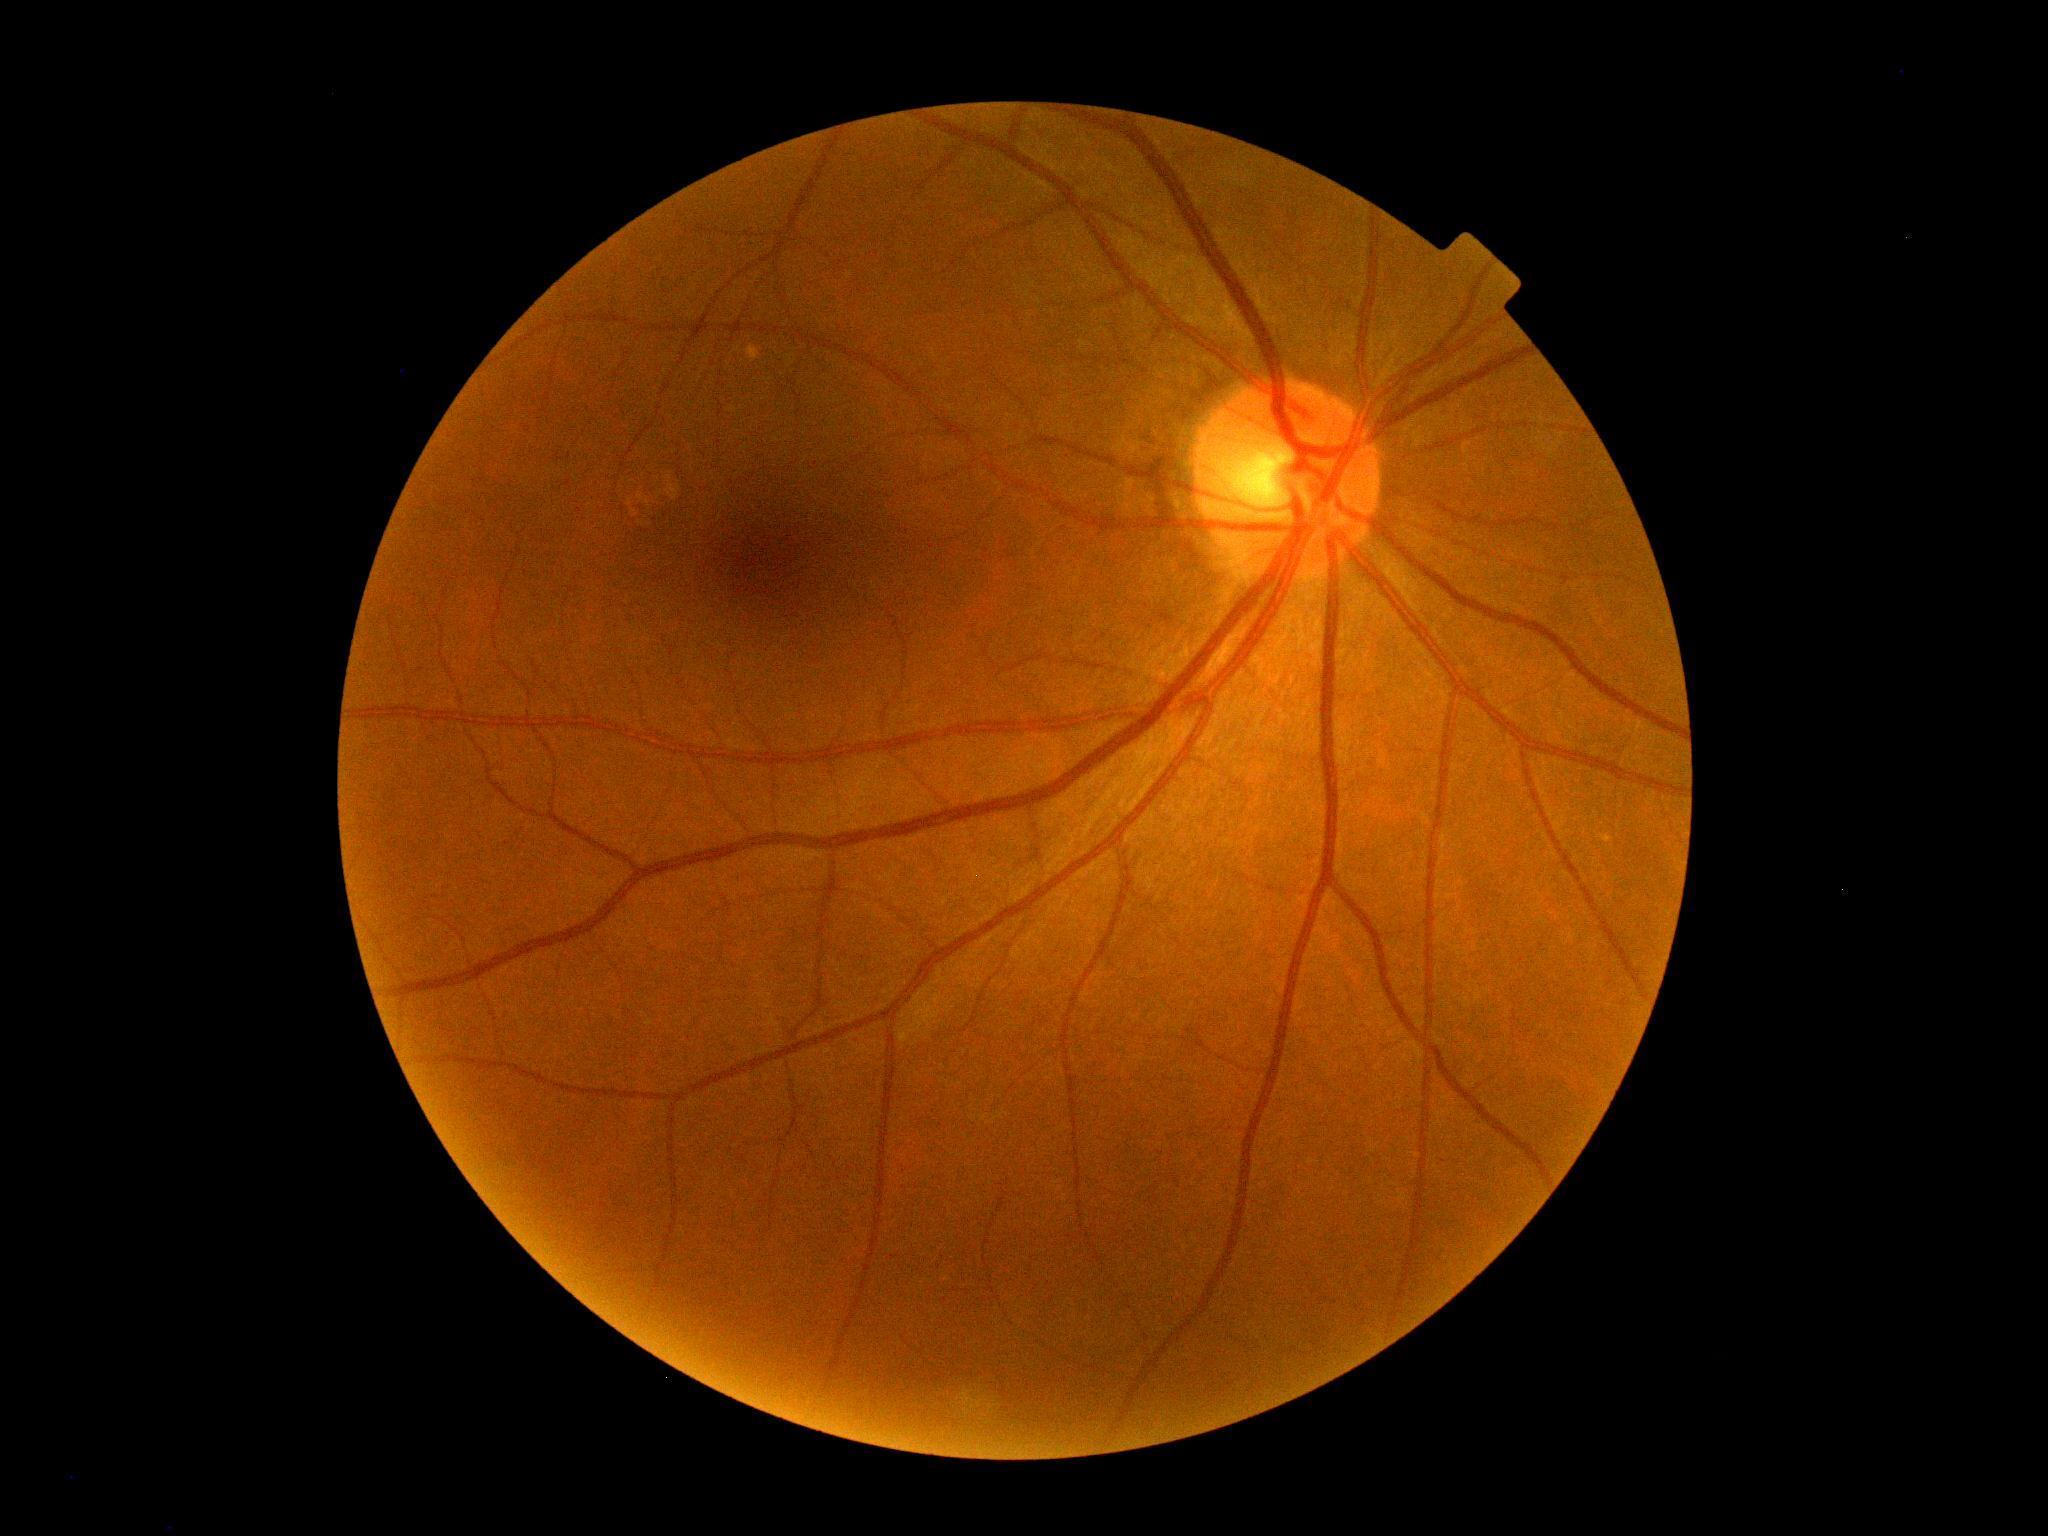 {
  "dr_grade": "0 — no visible signs of diabetic retinopathy",
  "dr_impression": "negative for DR"
}